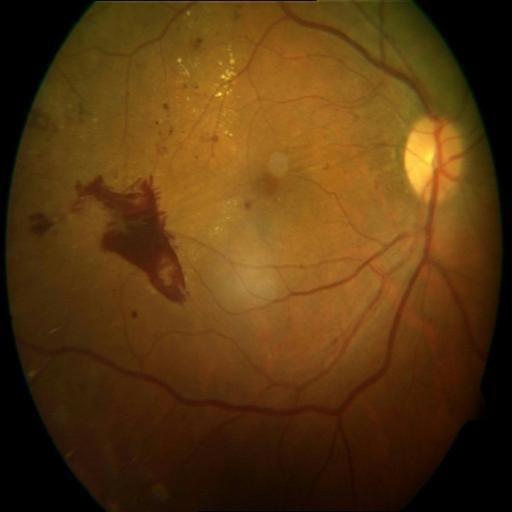

Fundus appearance consistent with preretinal hemorrhage, epiretinal membrane & exudation.